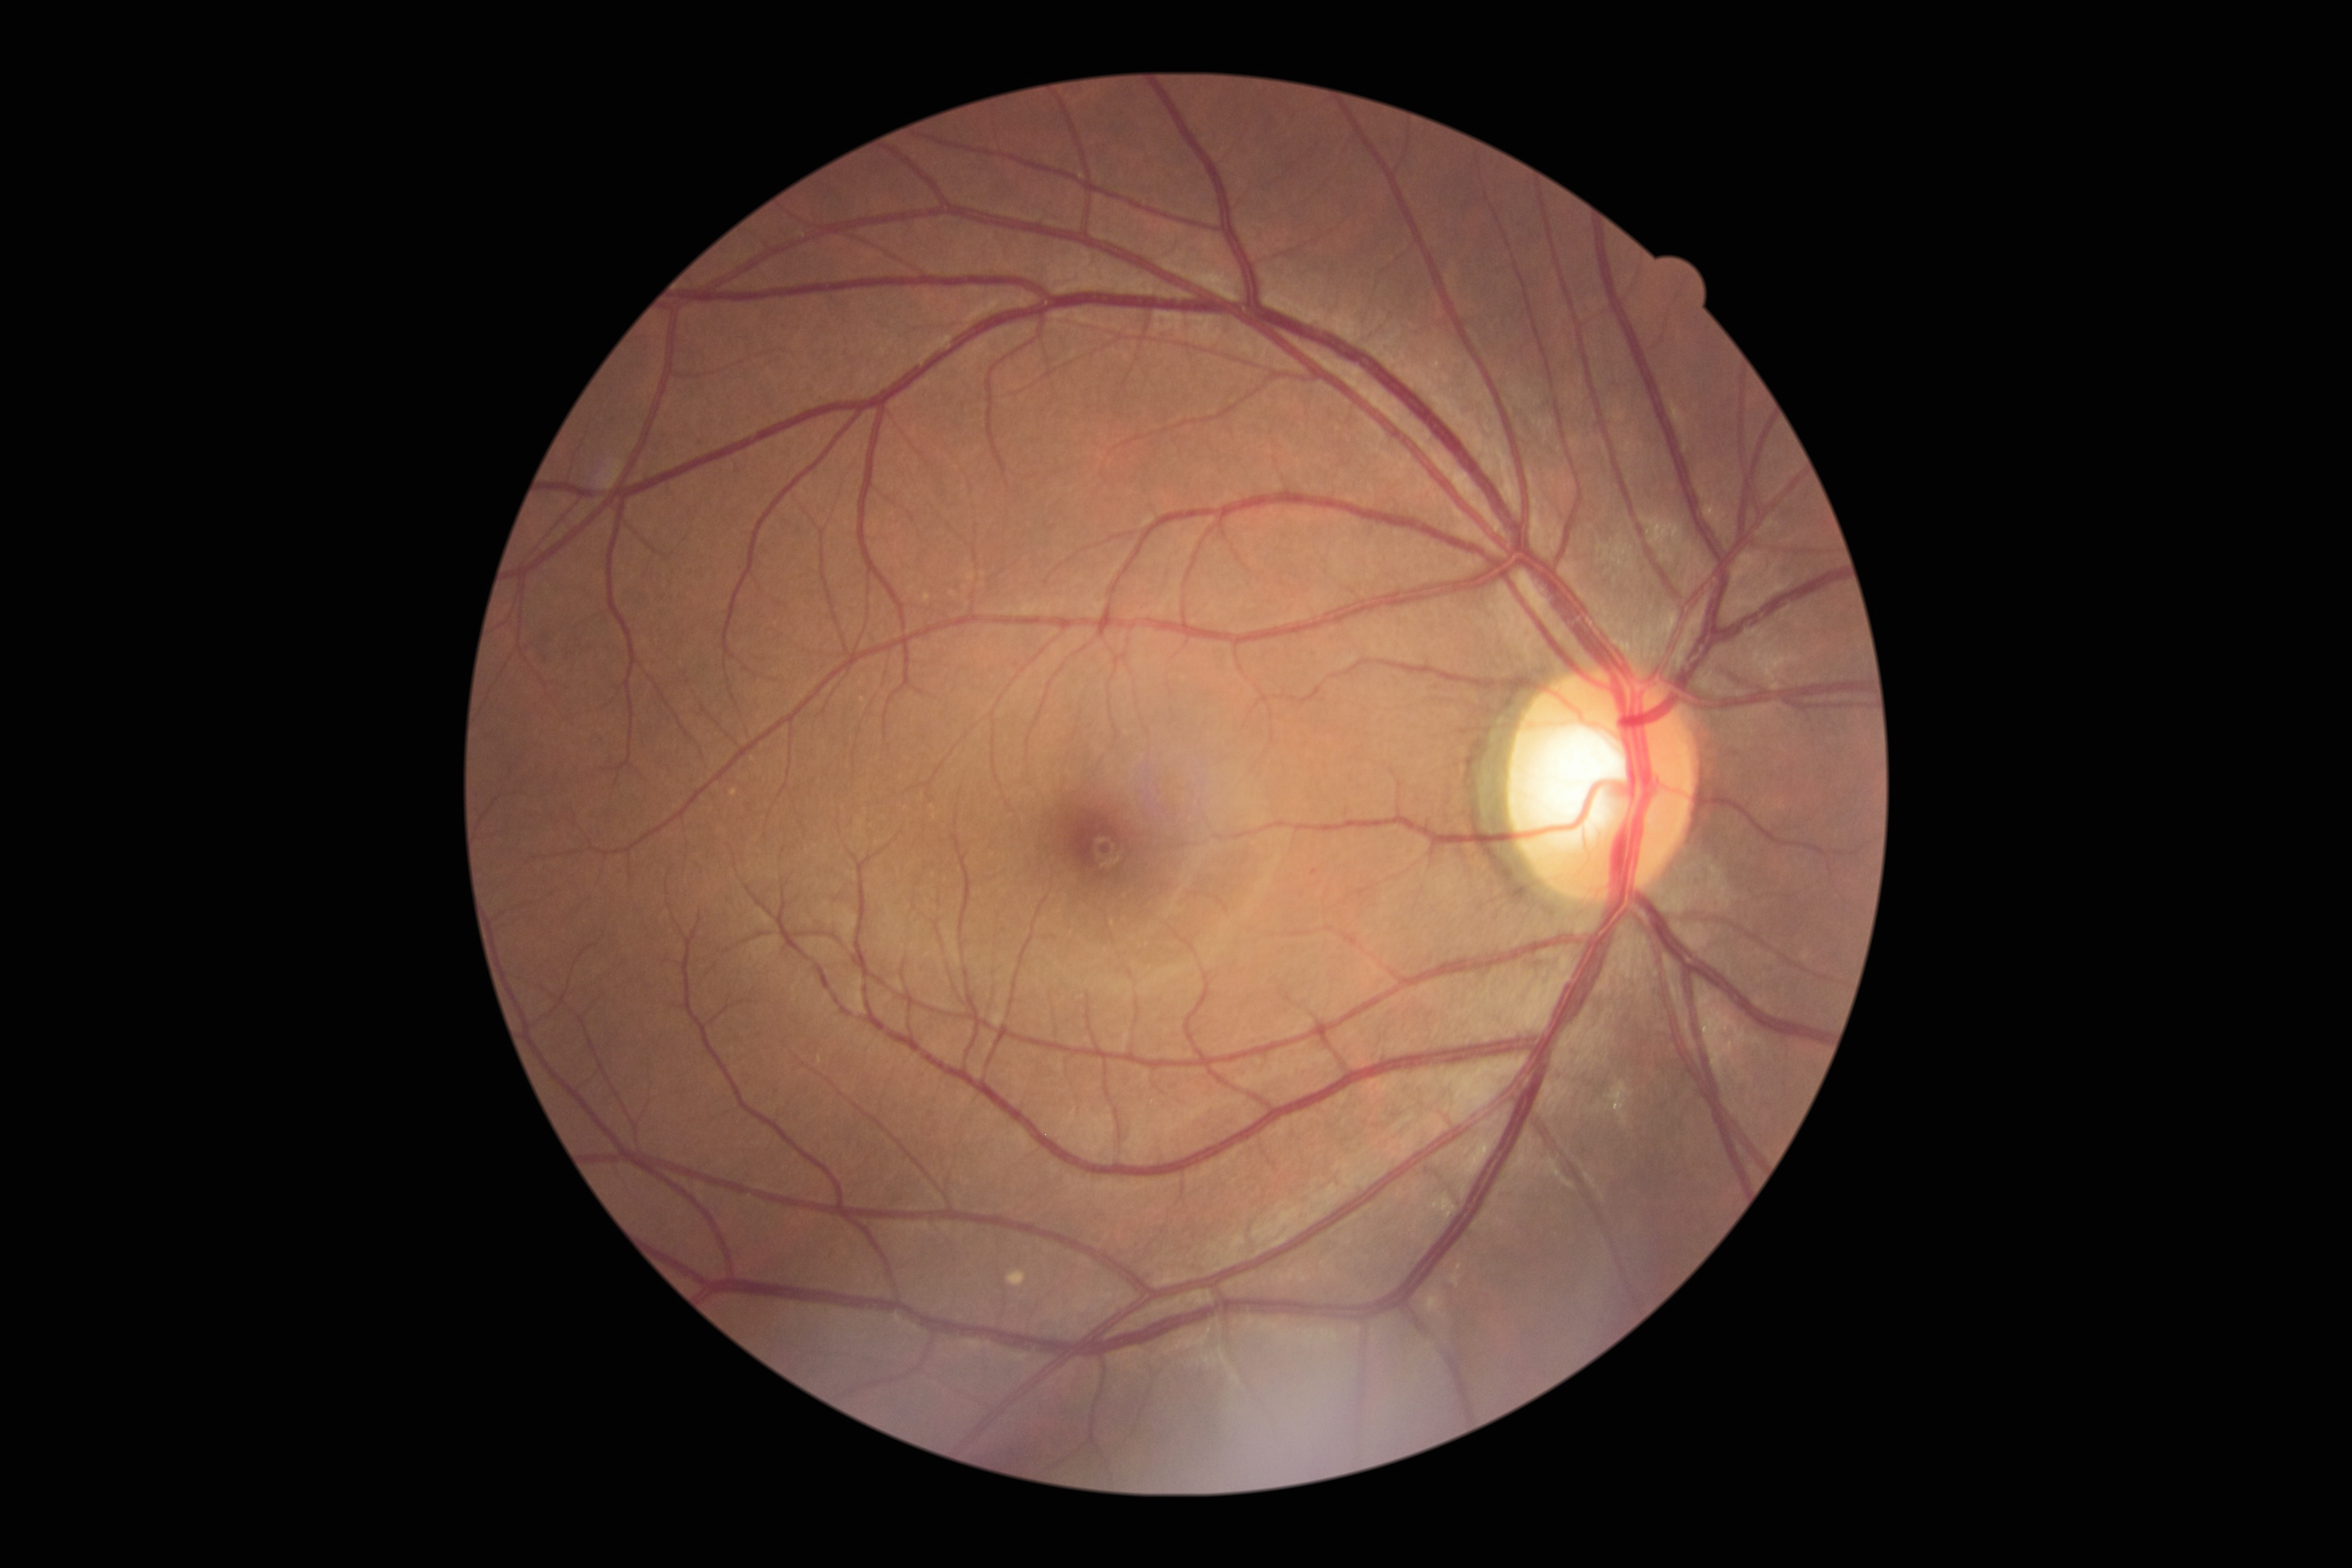
DR grade is no apparent diabetic retinopathy (0).